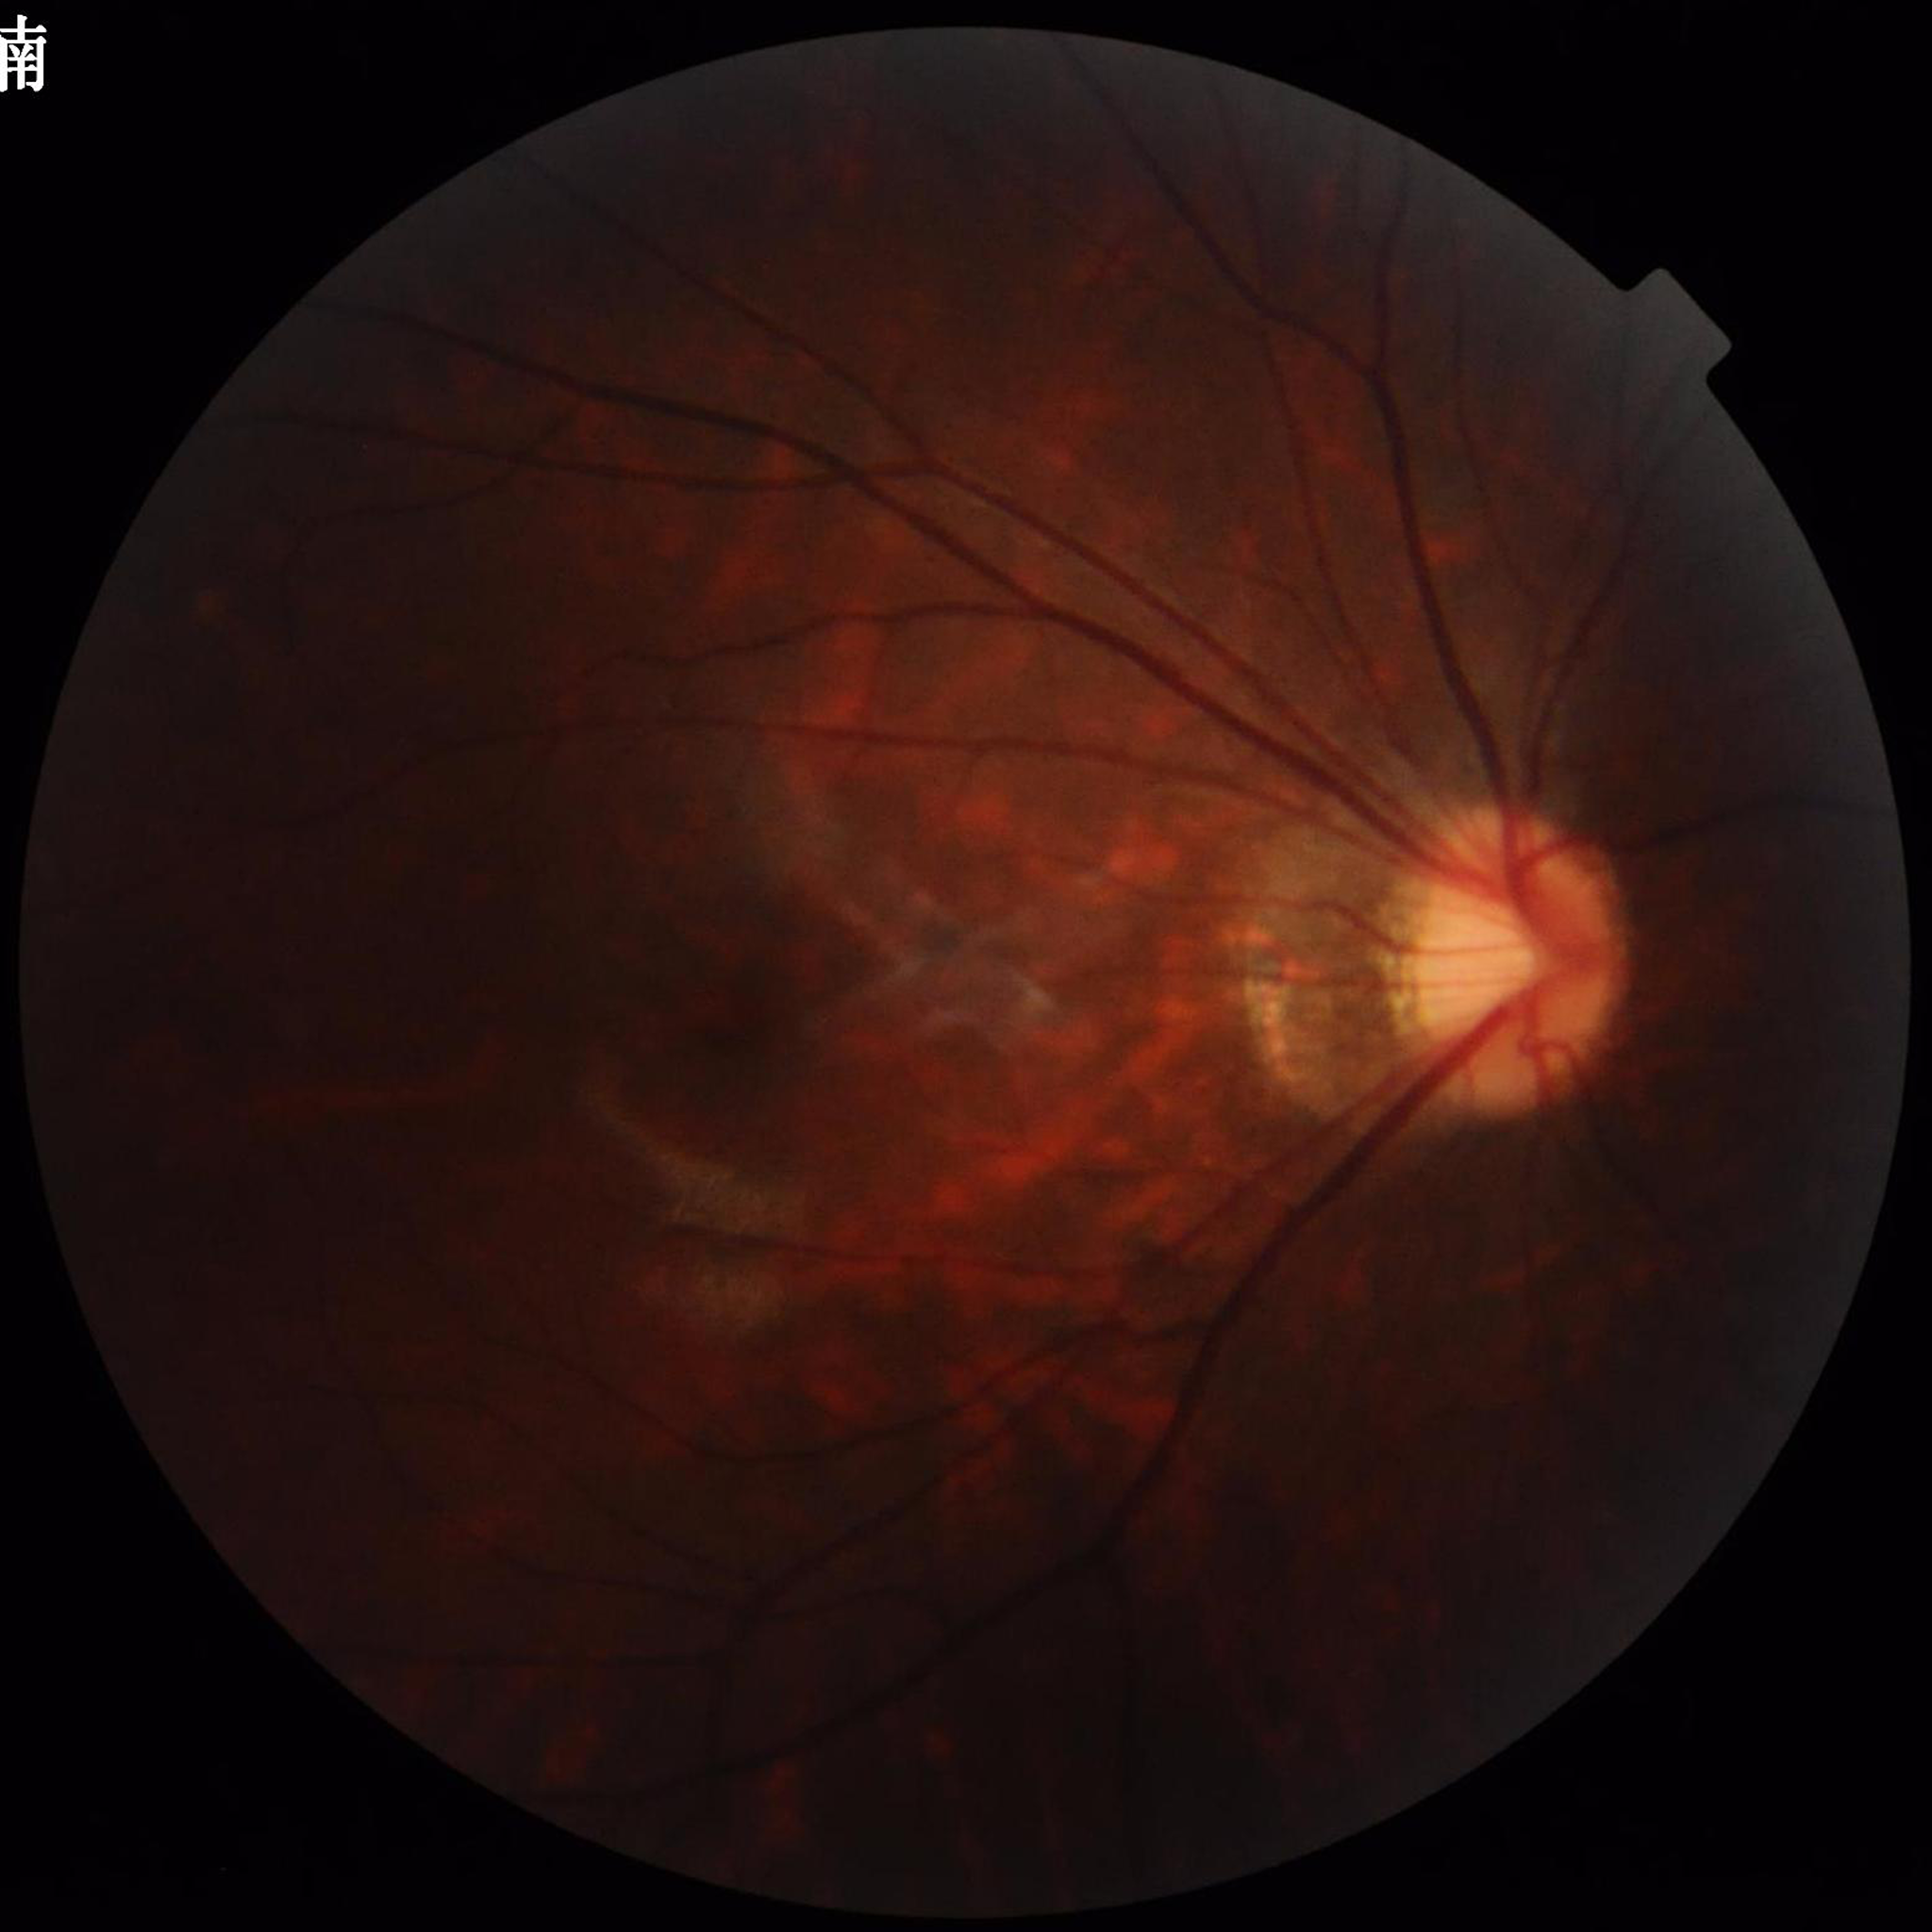

Image quality: reduced — illumination/color distortion.
Fundus image of an eye with glaucoma.